Camera: NIDEK AFC-230, posterior pole color fundus photograph — 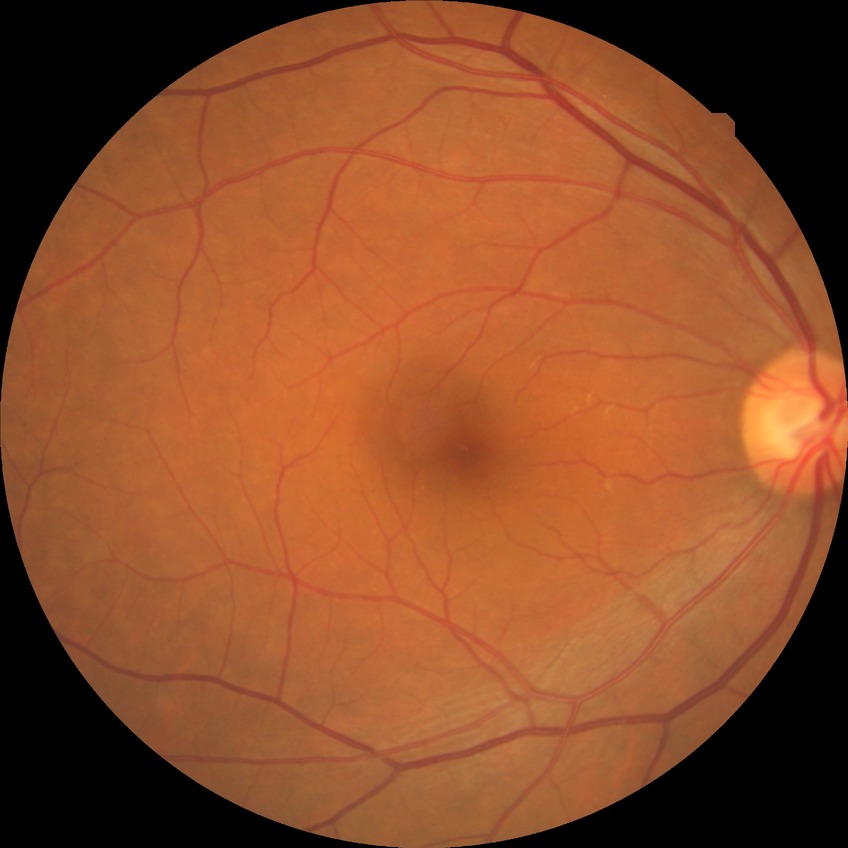 Diabetic retinopathy (DR) is NDR (no diabetic retinopathy).